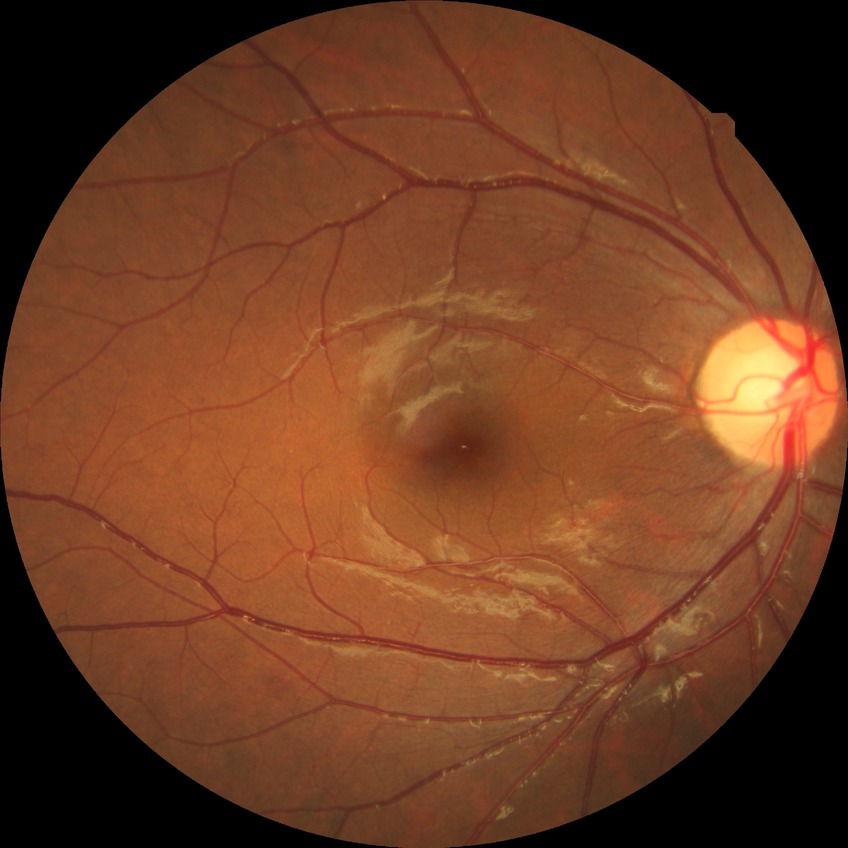

Diabetic retinopathy (DR): SDR (simple diabetic retinopathy).